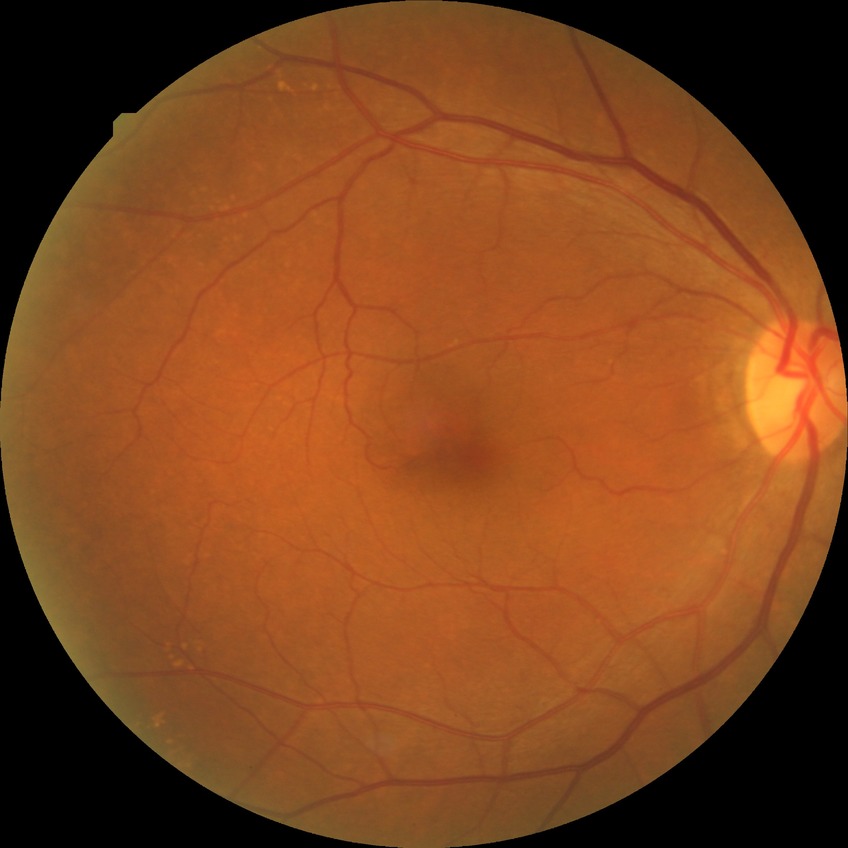
Assessment:
* diabetic retinopathy (DR): NDR (no diabetic retinopathy)